1932 x 1910 pixels:
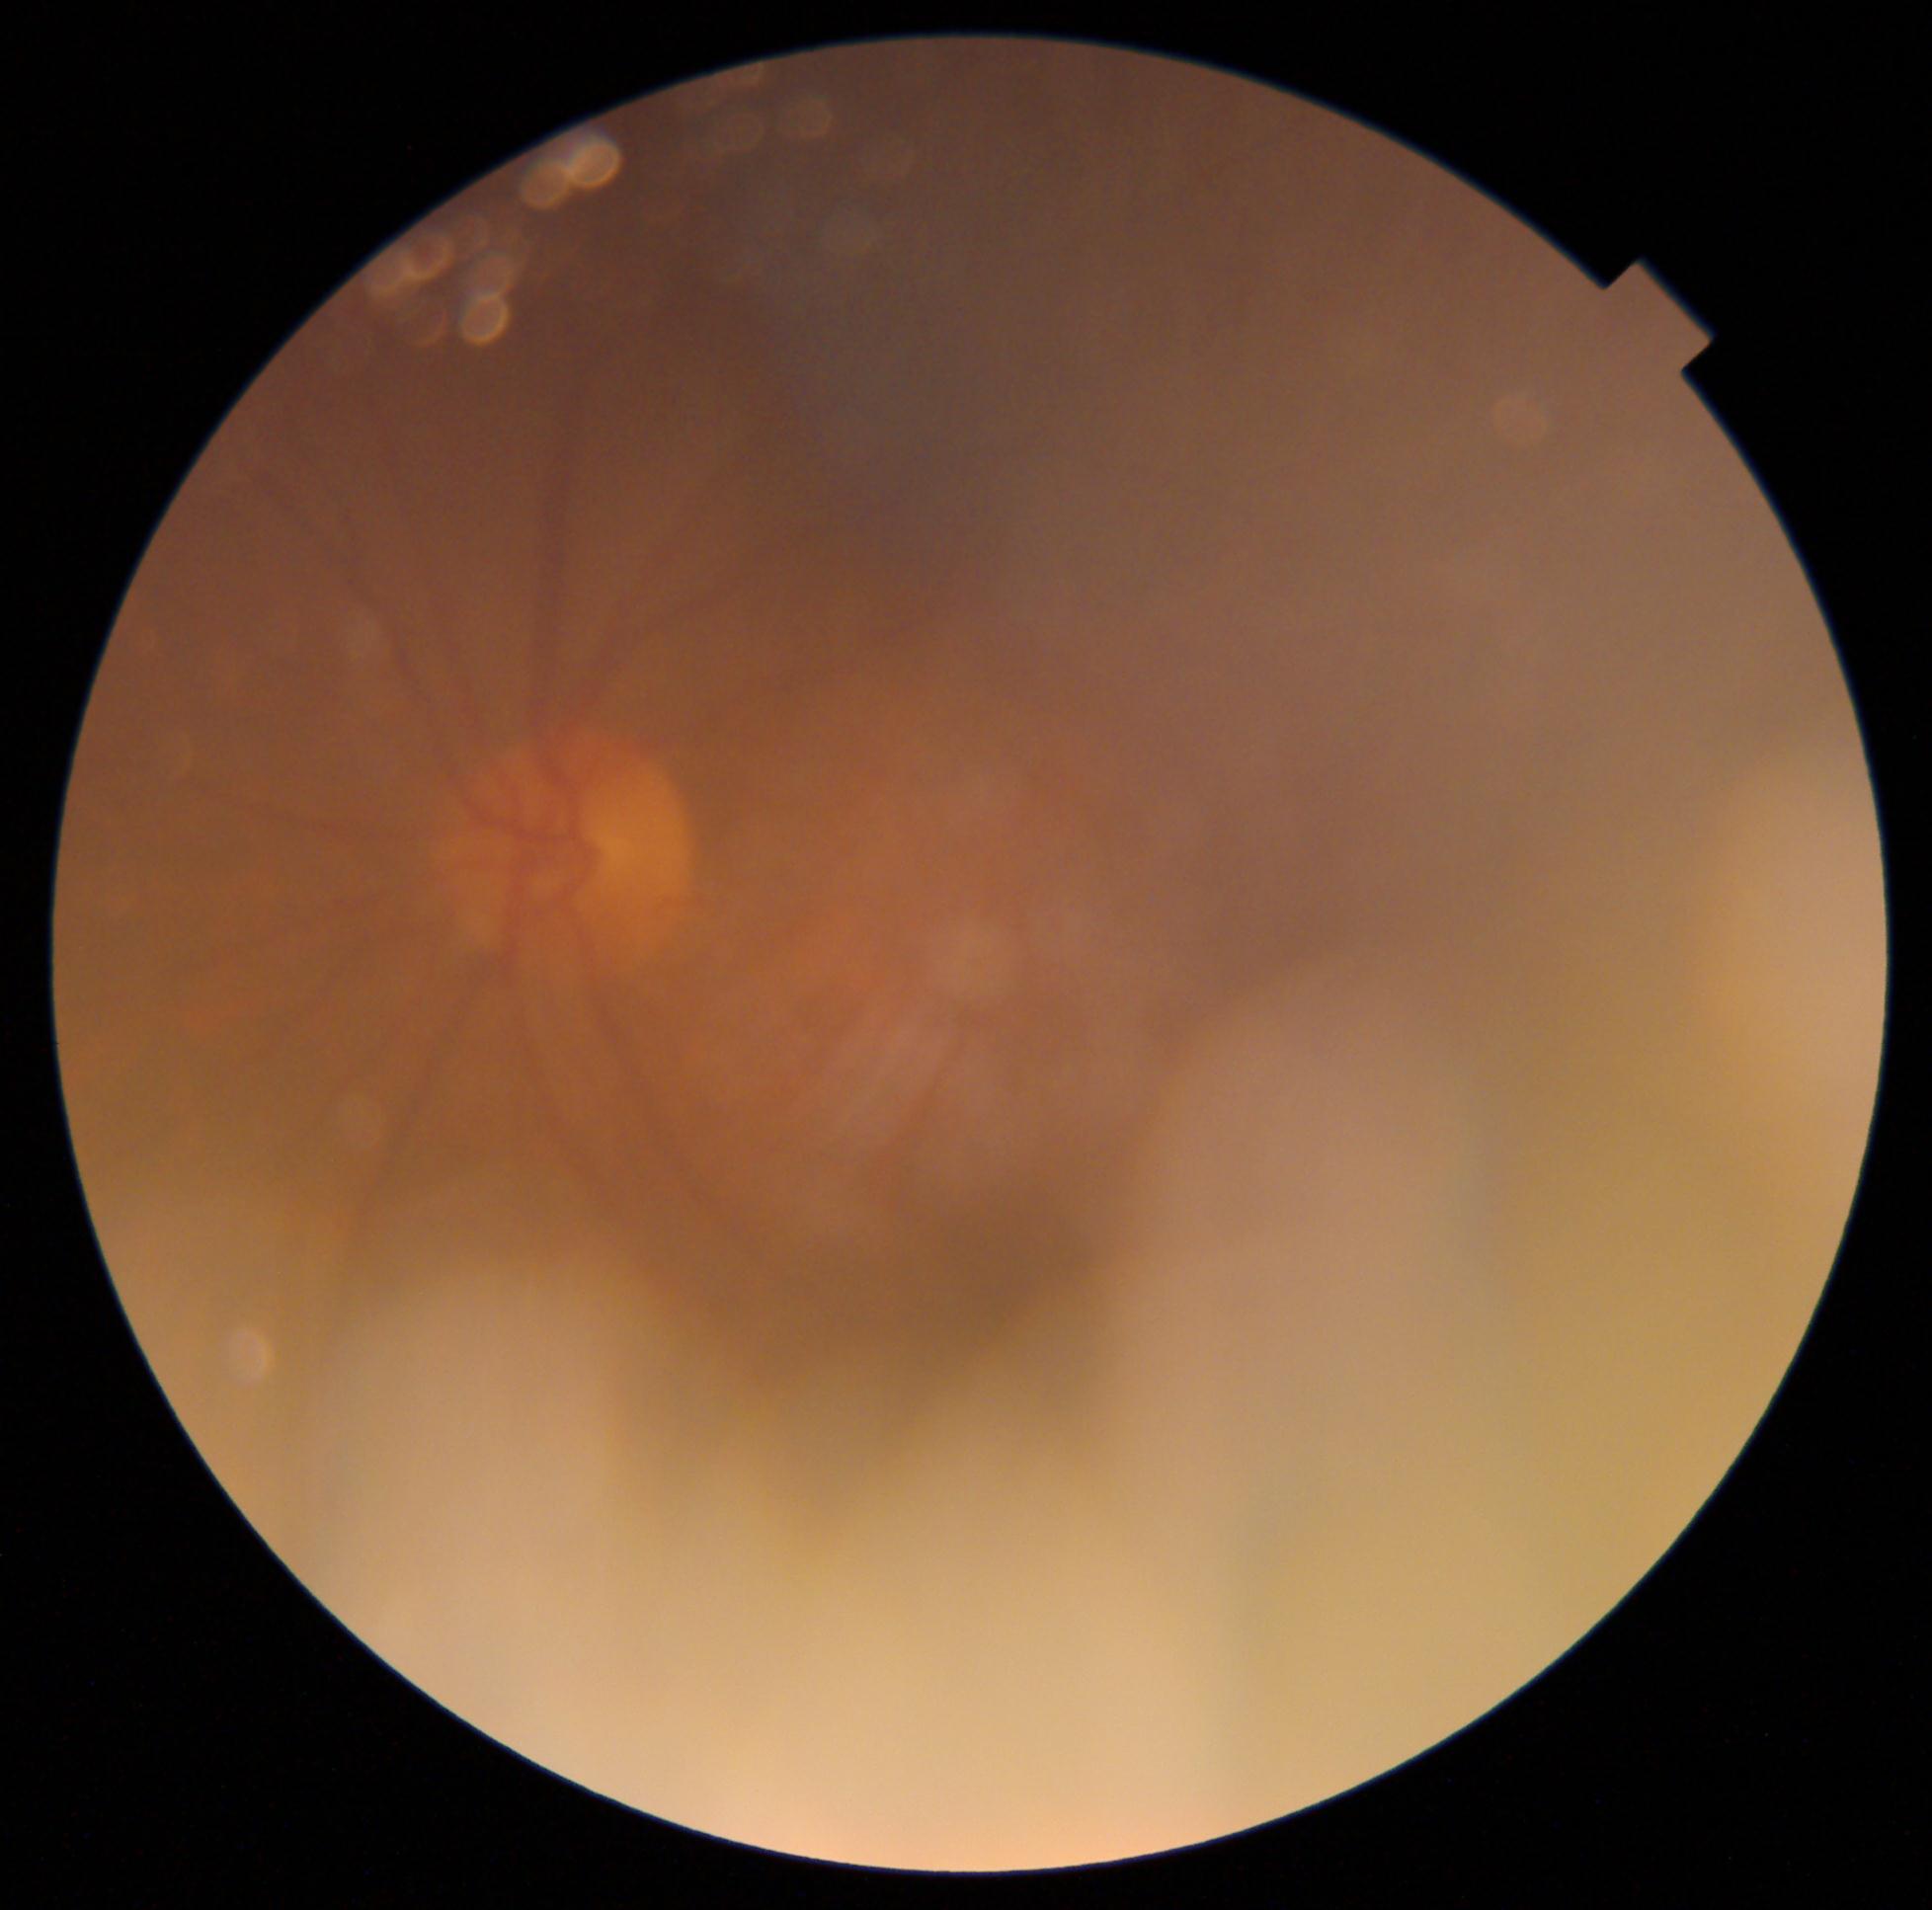
{"dr_grade": "ungradable due to poor image quality", "quality": "below grading threshold"}